Acquired with a NIDEK AFC-230.
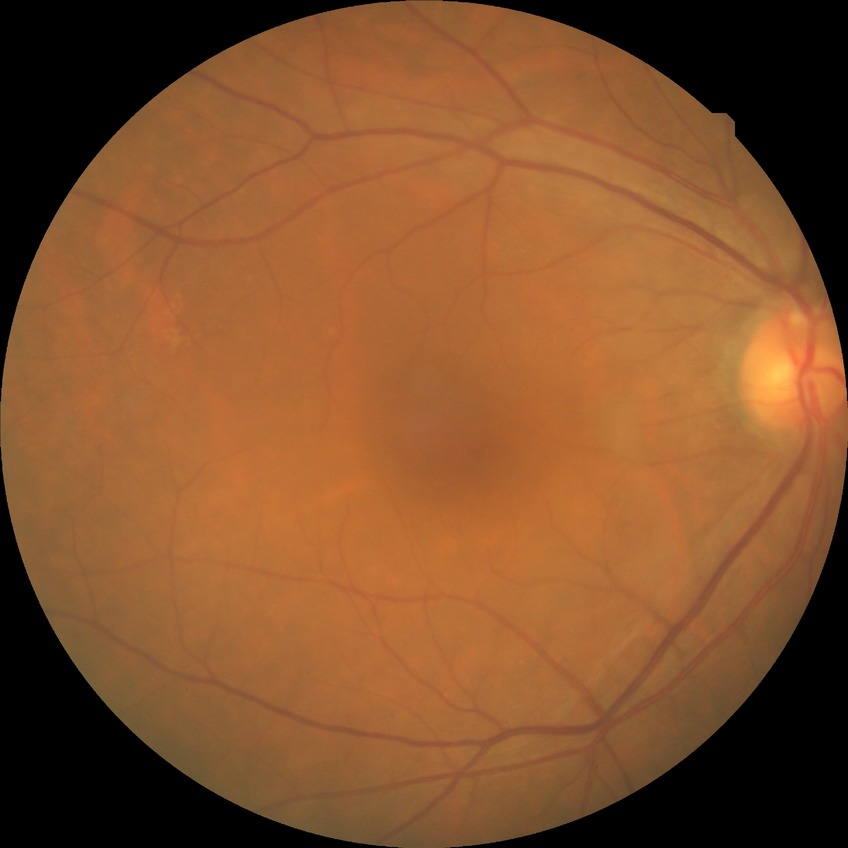

Diabetic retinopathy (DR): no diabetic retinopathy (NDR).